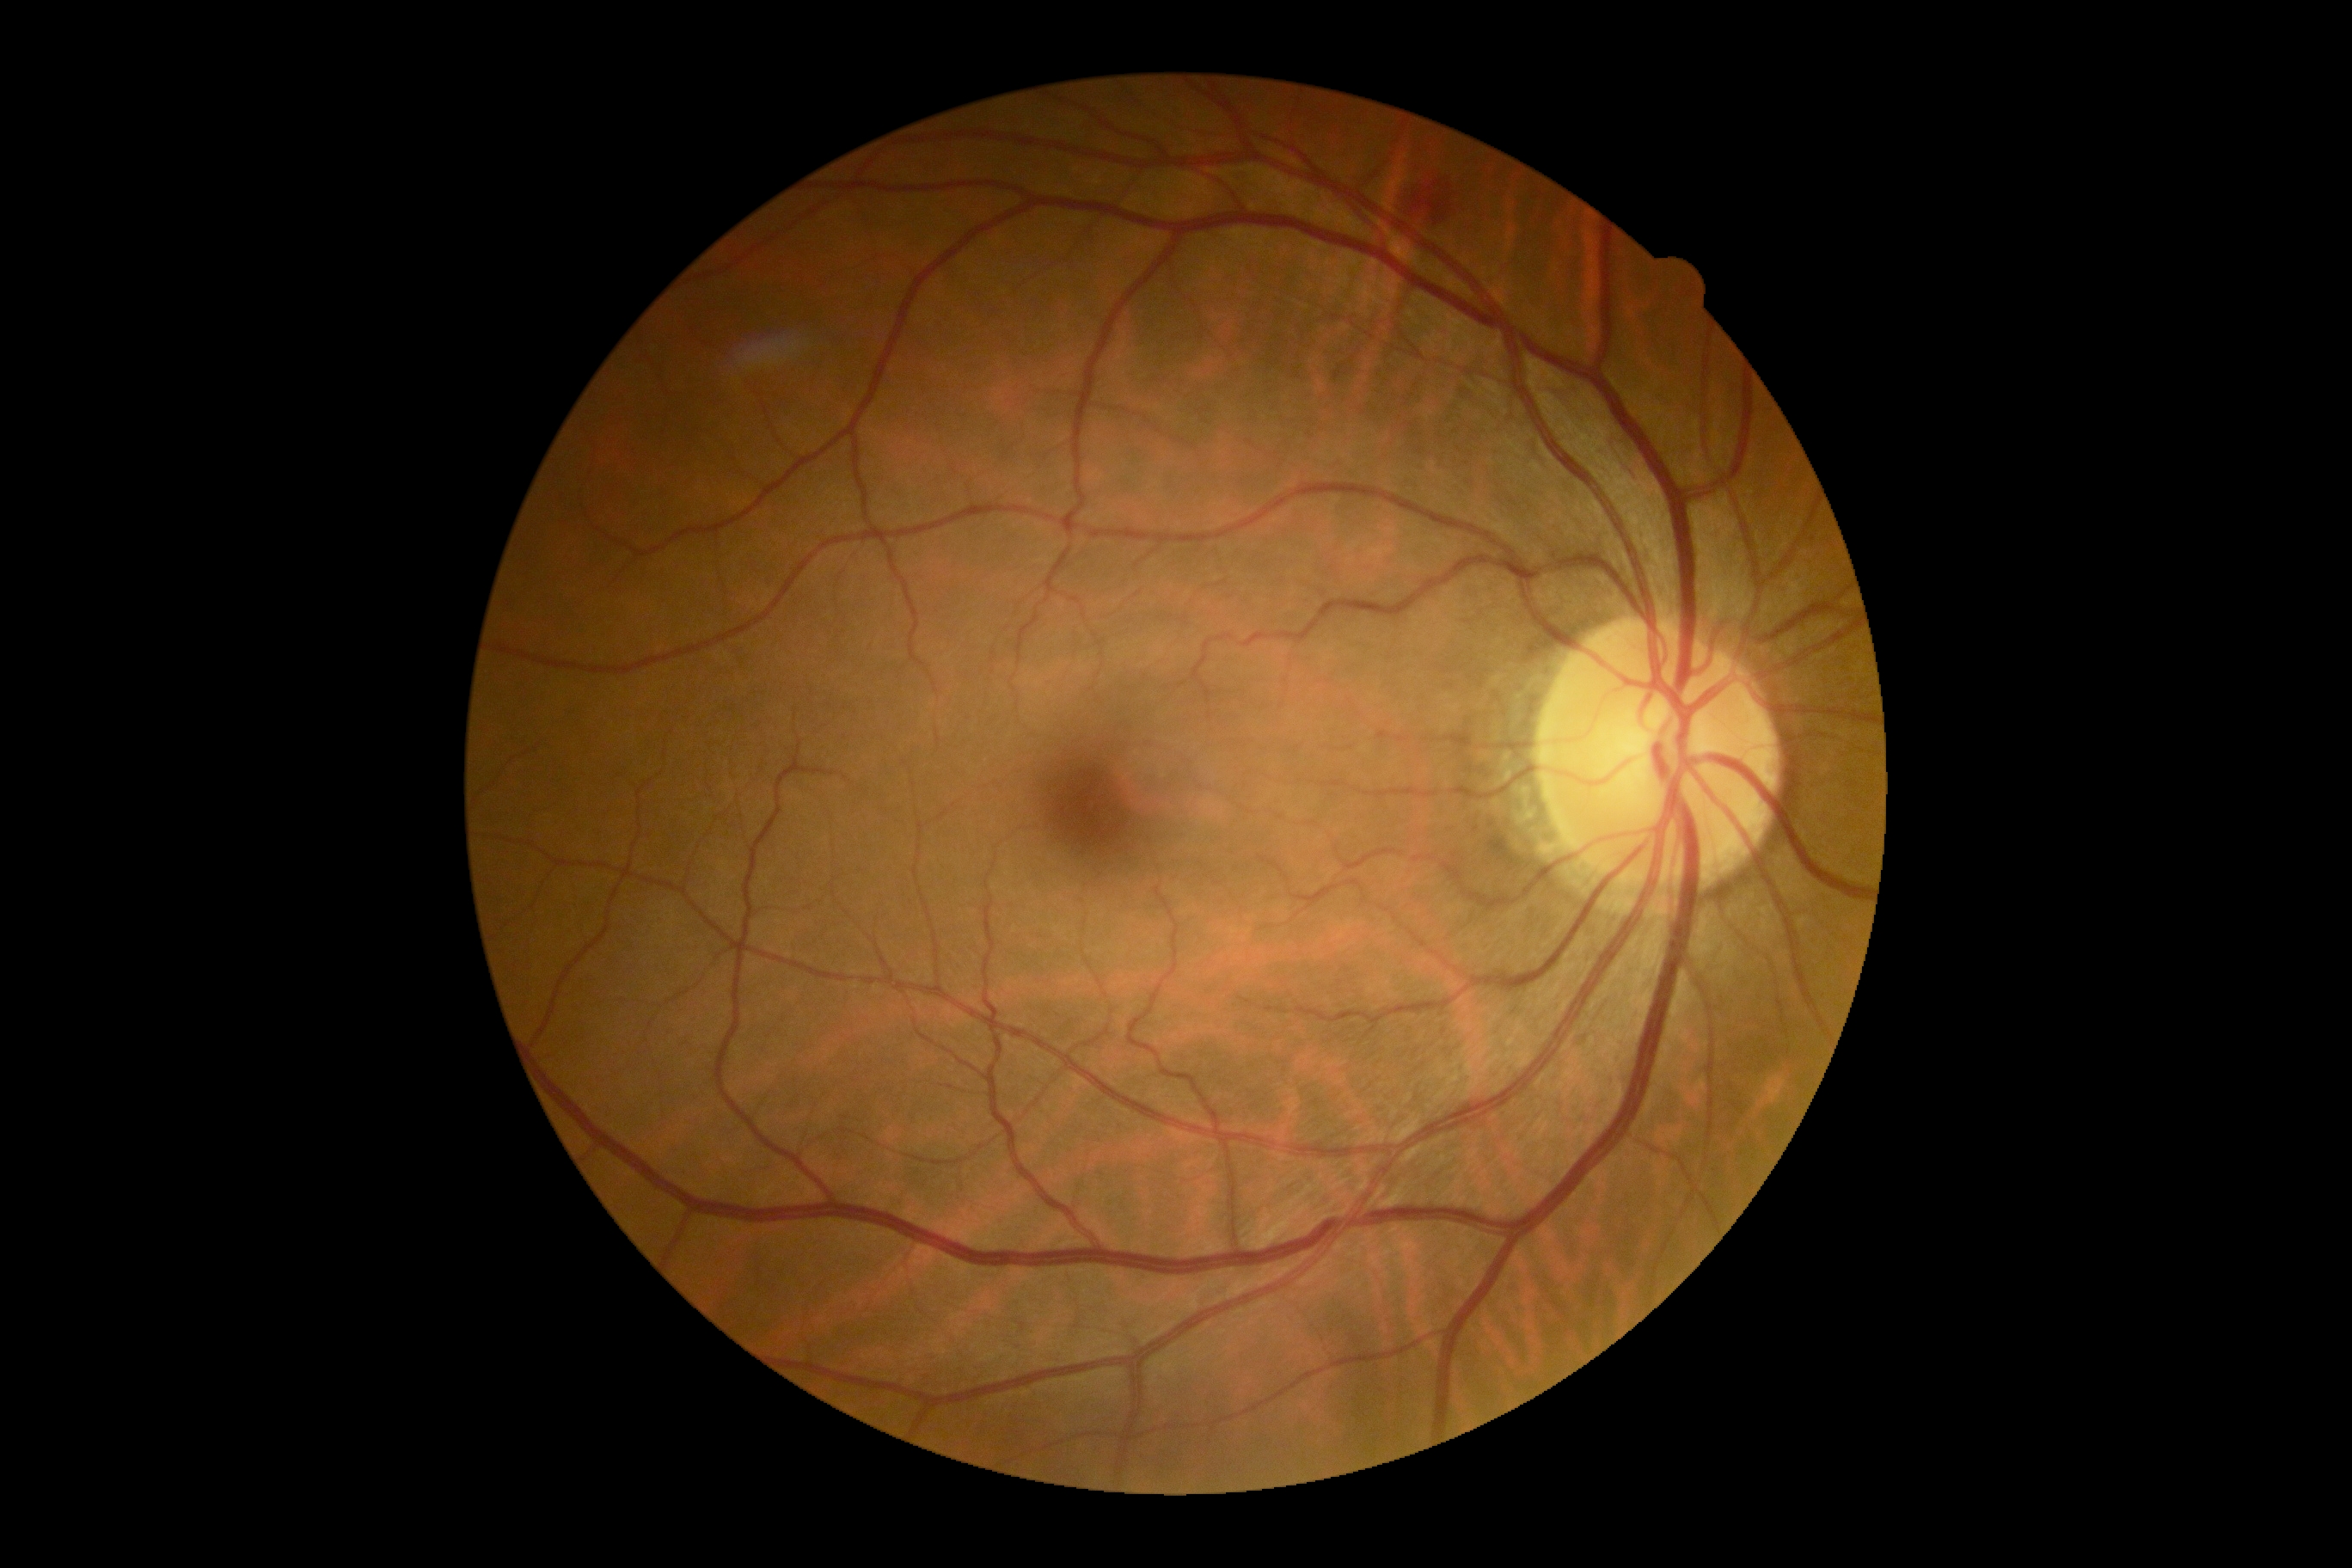
Annotations:
- diabetic retinopathy (DR) — grade 2 (moderate NPDR)
- DR class — non-proliferative diabetic retinopathy